Color fundus photograph.
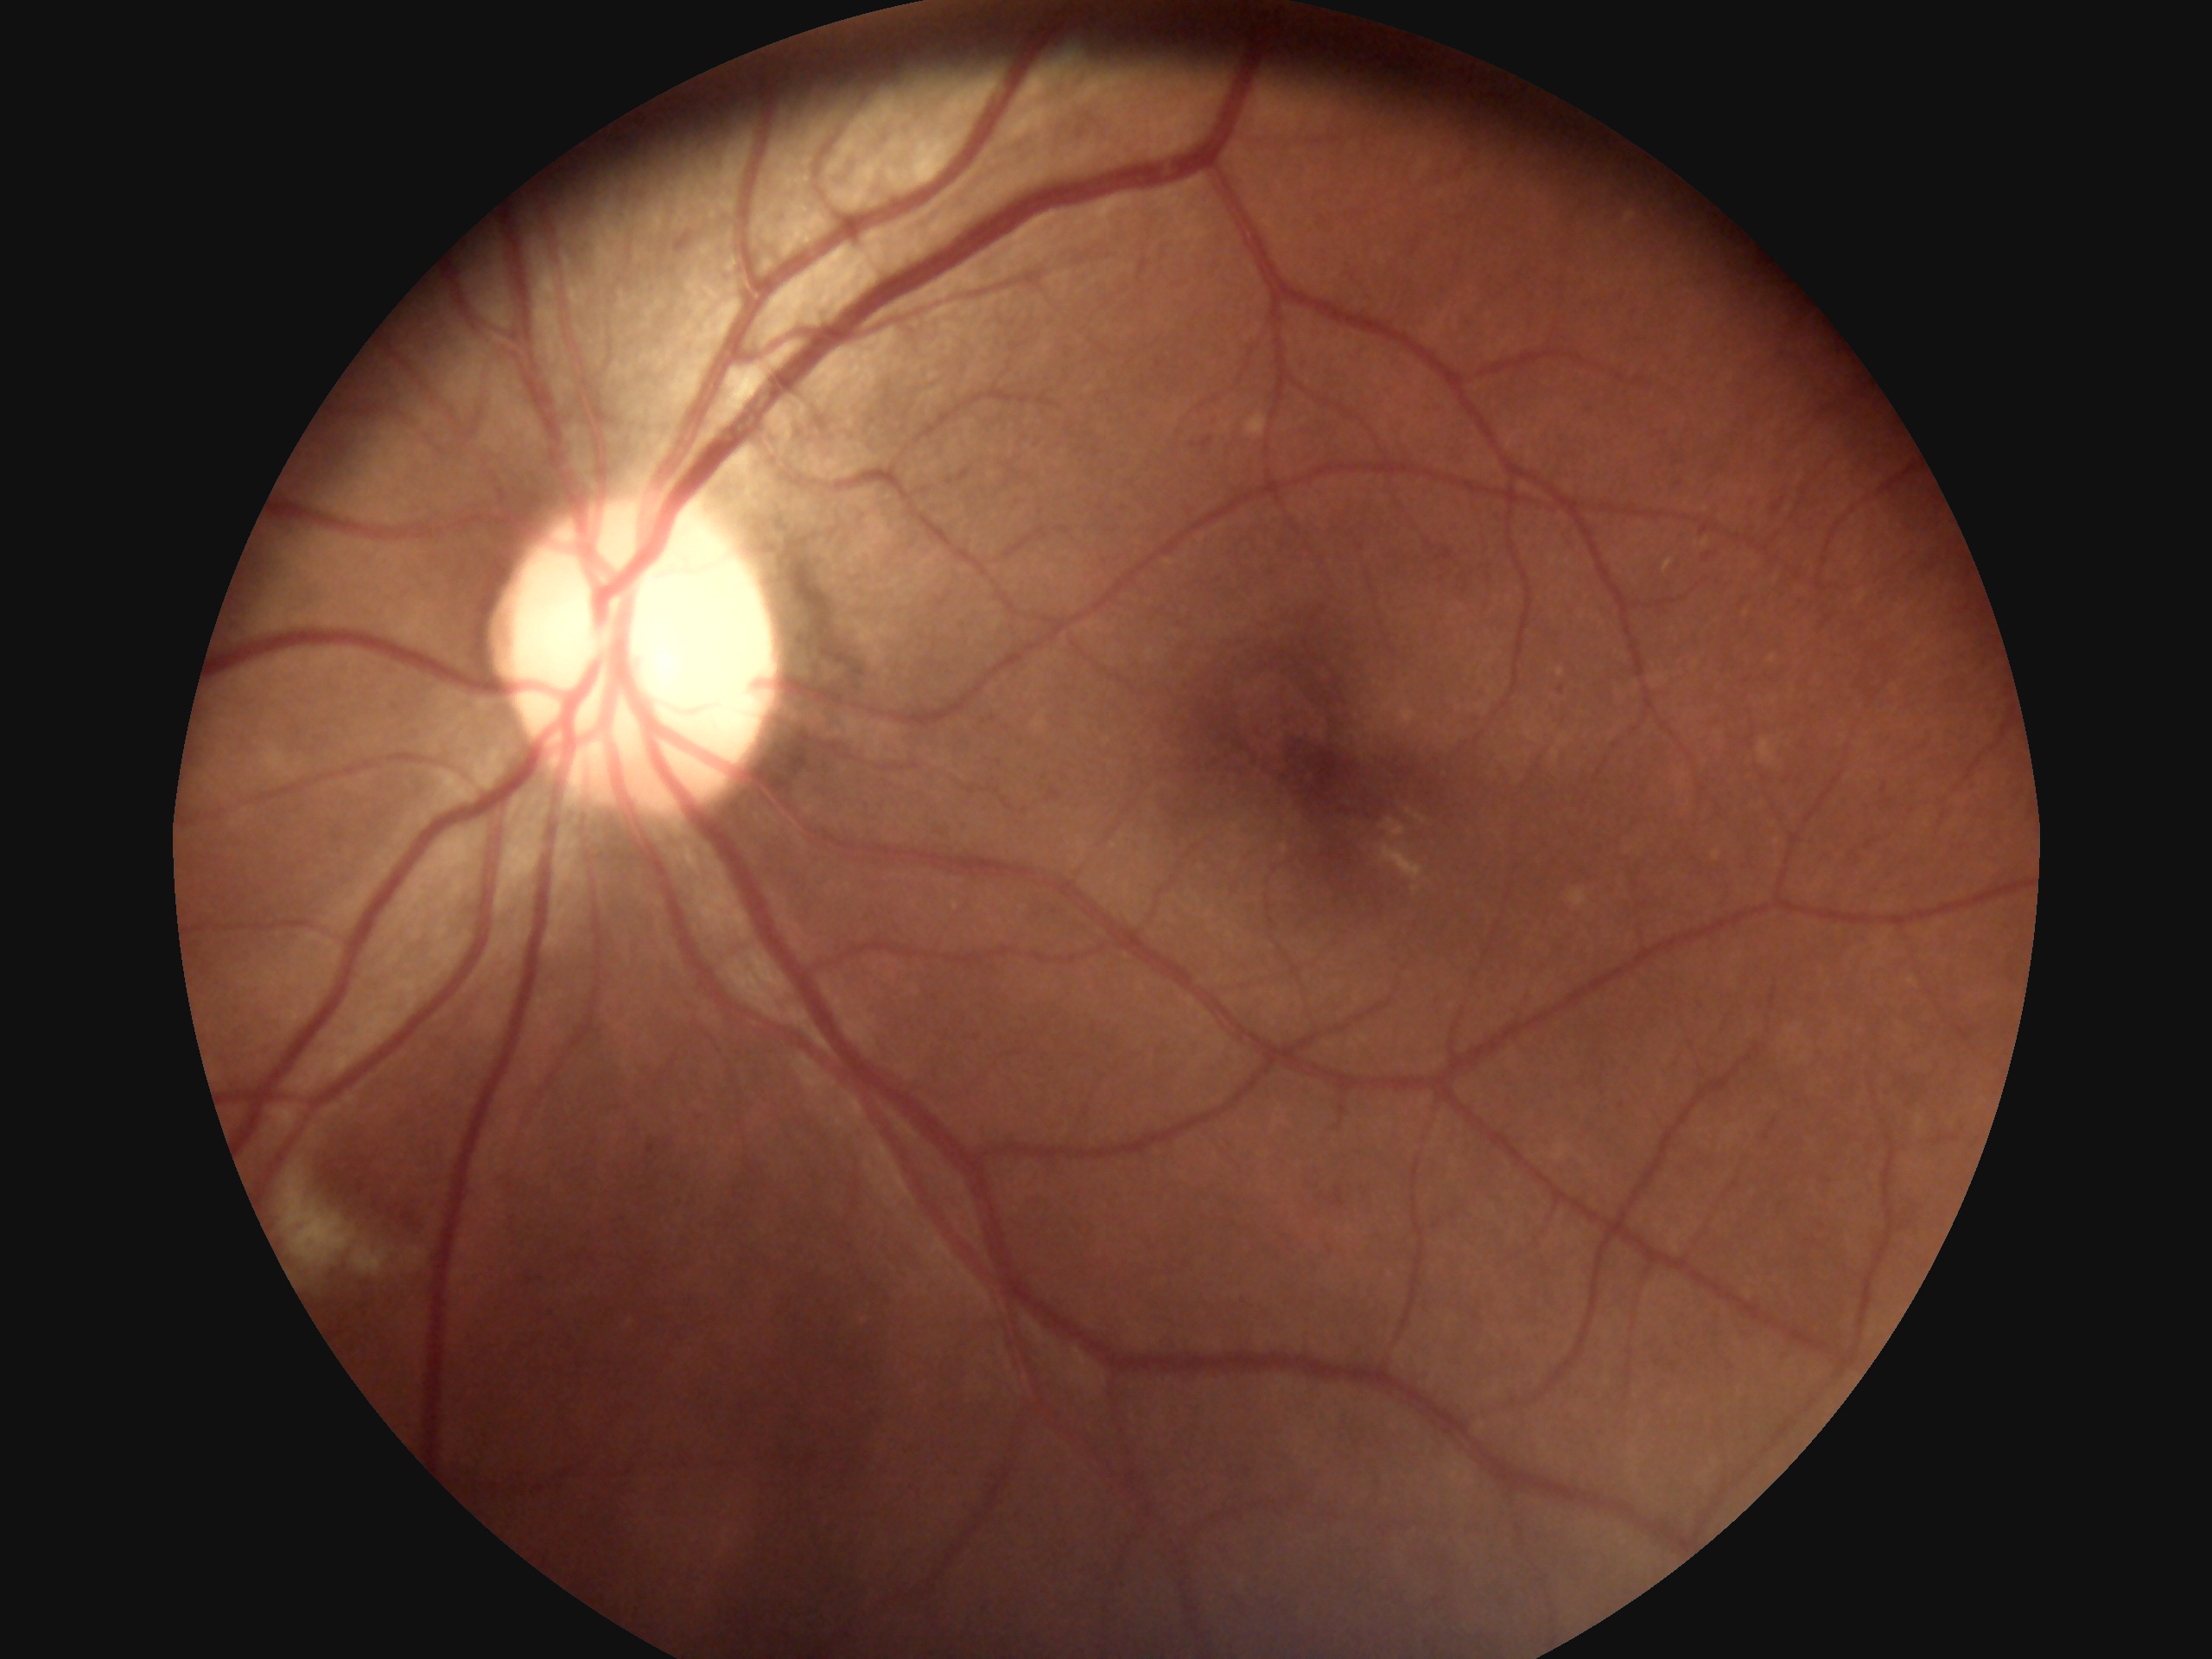
DR severity: 2/4 — more than just microaneurysms but less than severe NPDR.